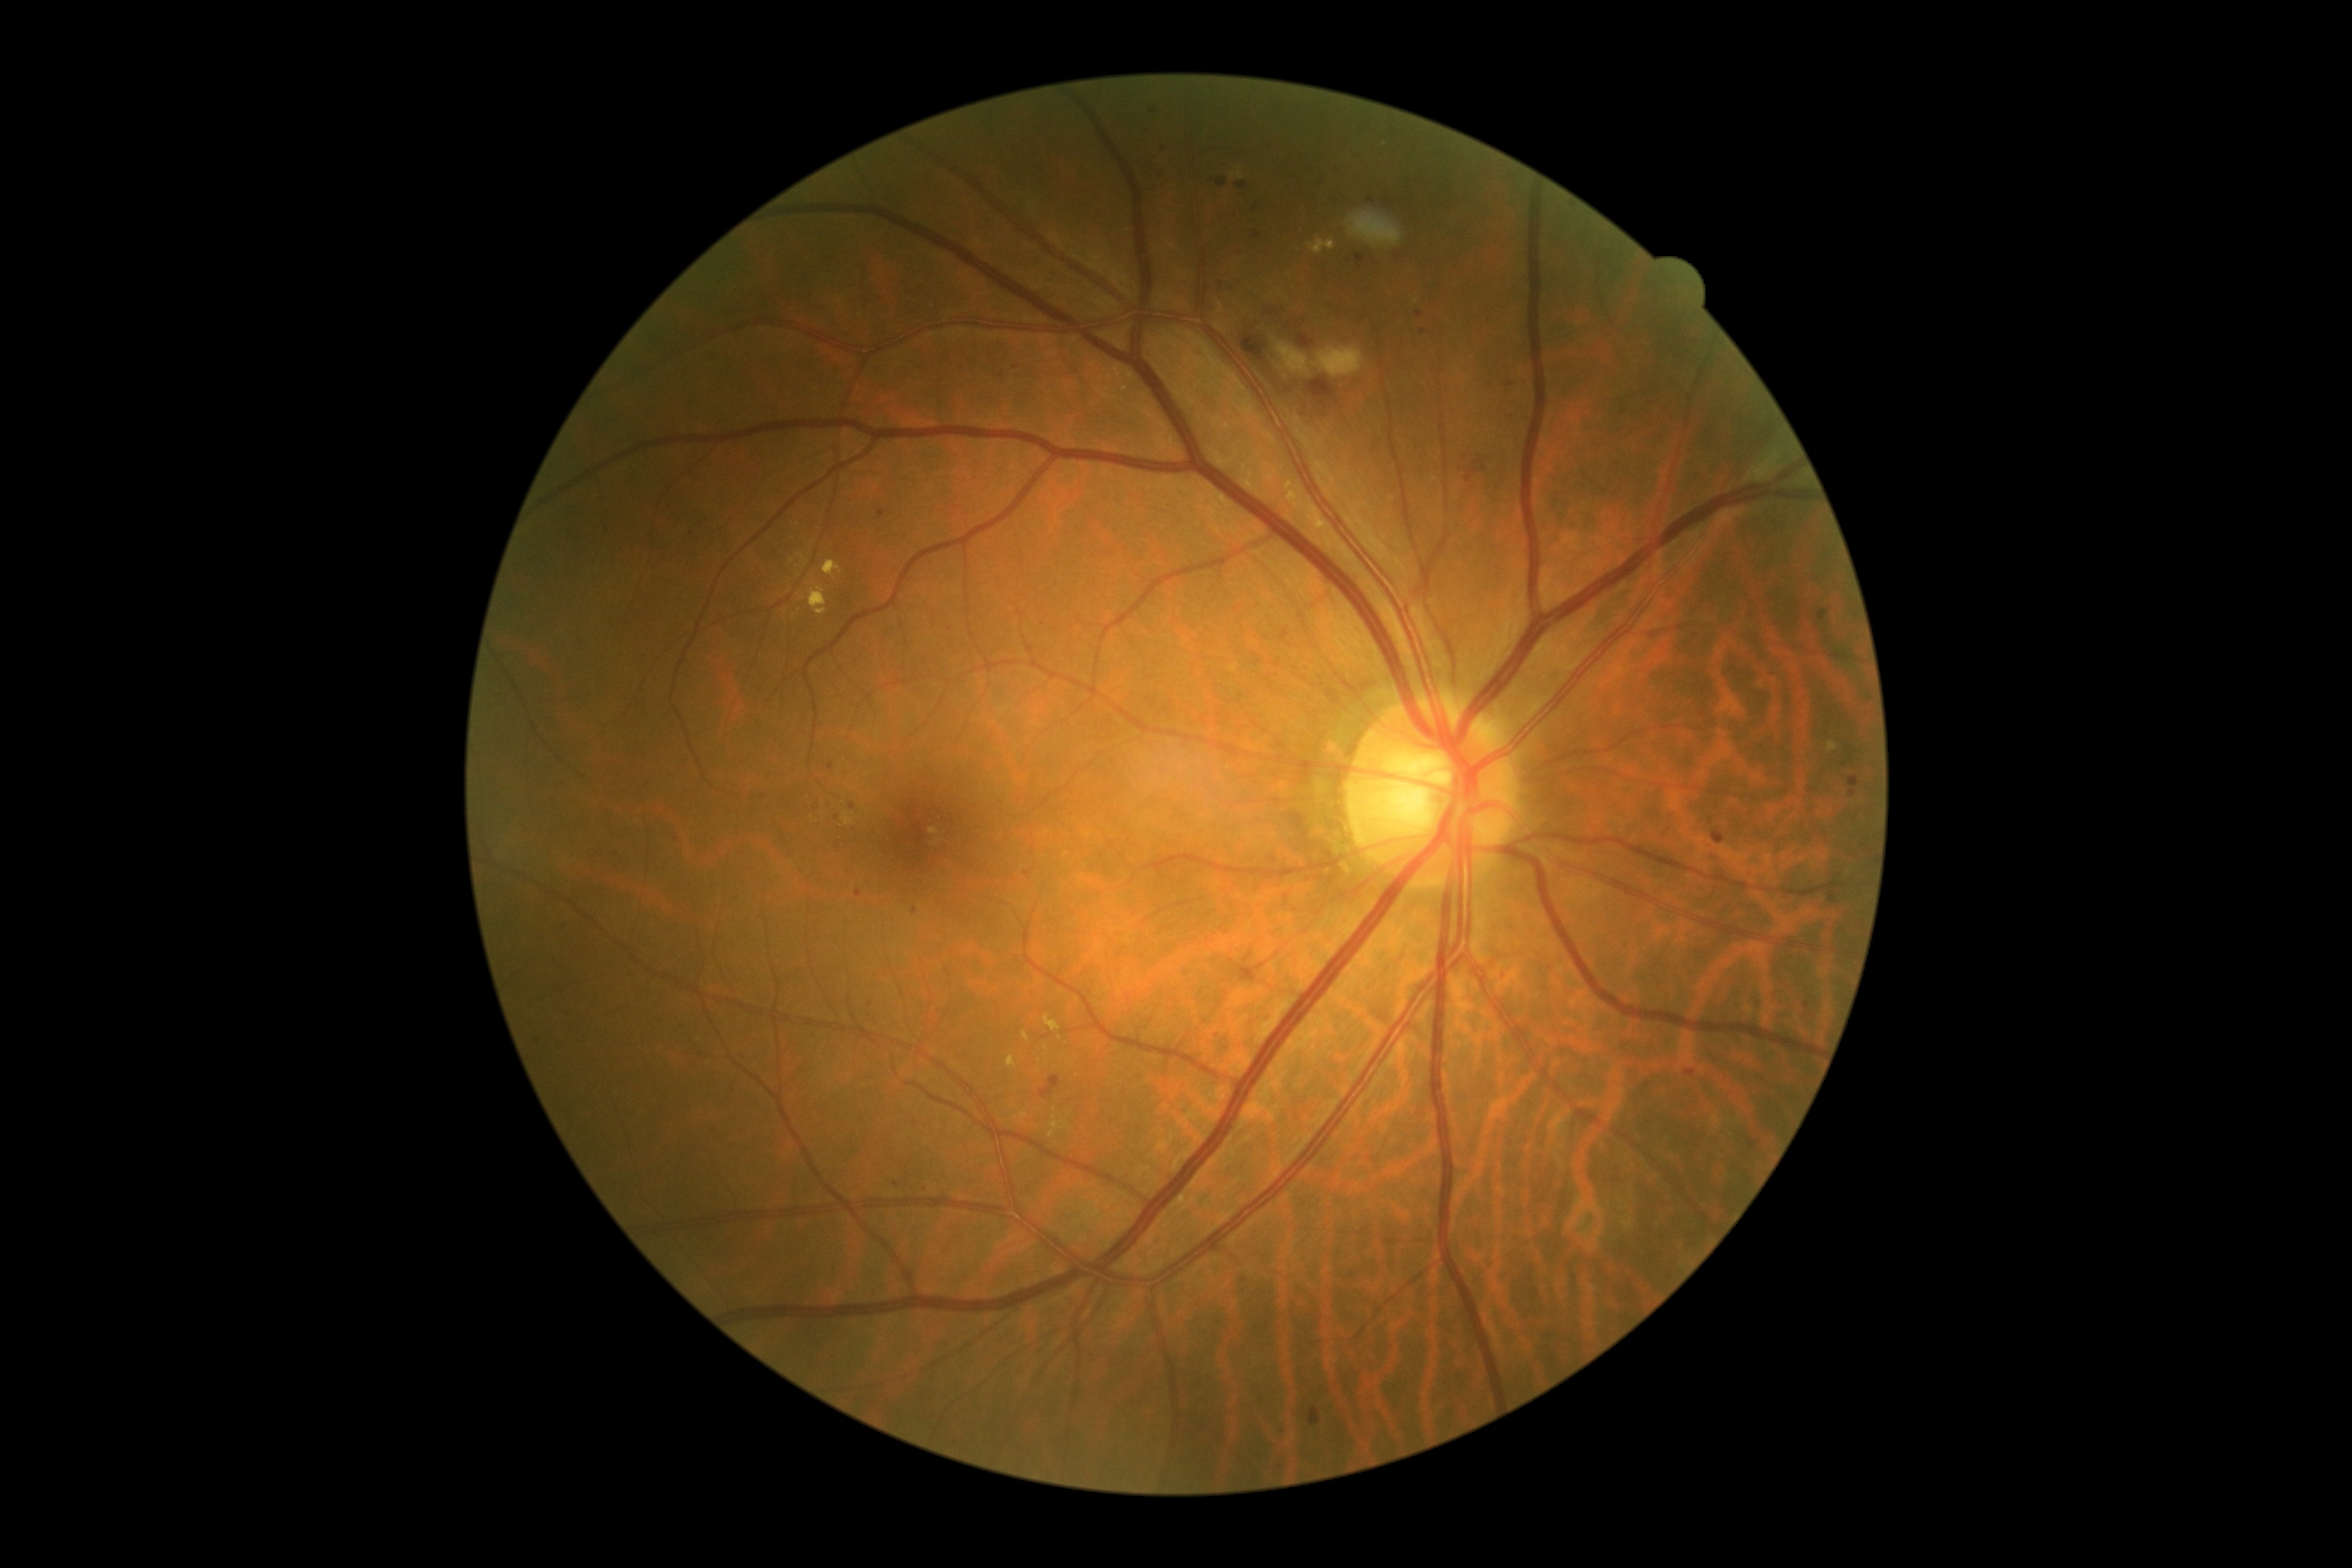 DR severity: grade 2 (moderate NPDR)
Representative lesions:
SEs: x1=1311 y1=346 x2=1366 y2=377; x1=1277 y1=341 x2=1311 y2=377
EXs (subset): x1=1287 y1=489 x2=1330 y2=530; x1=1308 y1=238 x2=1337 y2=255; x1=1287 y1=481 x2=1294 y2=491; x1=1007 y1=1057 x2=1017 y2=1069; x1=823 y1=560 x2=842 y2=579; x1=1828 y1=742 x2=1837 y2=752
Additional small EXs near [1046,1048]; [804,565]; [1385,145]; [1245,467]; [802,598]; [1240,176]; [1068,1127]
HEs (subset): x1=1242 y1=336 x2=1265 y2=362; x1=1308 y1=377 x2=1335 y2=401; x1=1297 y1=334 x2=1313 y2=348
Additional small HEs near [1268,313]; [1287,391]
MAs (subset): x1=855 y1=890 x2=862 y2=898; x1=1748 y1=1139 x2=1761 y2=1151; x1=1684 y1=1070 x2=1696 y2=1077; x1=1308 y1=1407 x2=1321 y2=1426; x1=1466 y1=458 x2=1488 y2=484; x1=1547 y1=675 x2=1564 y2=682; x1=1828 y1=895 x2=1837 y2=903; x1=1818 y1=611 x2=1828 y2=622; x1=1216 y1=180 x2=1228 y2=188
Additional small MAs near [895,1184]; [1001,376]; [1852,795]; [1371,199]; [676,840]; [570,924]; [851,807]; [830,767]; [1165,150]; [1422,331]; [1256,208]